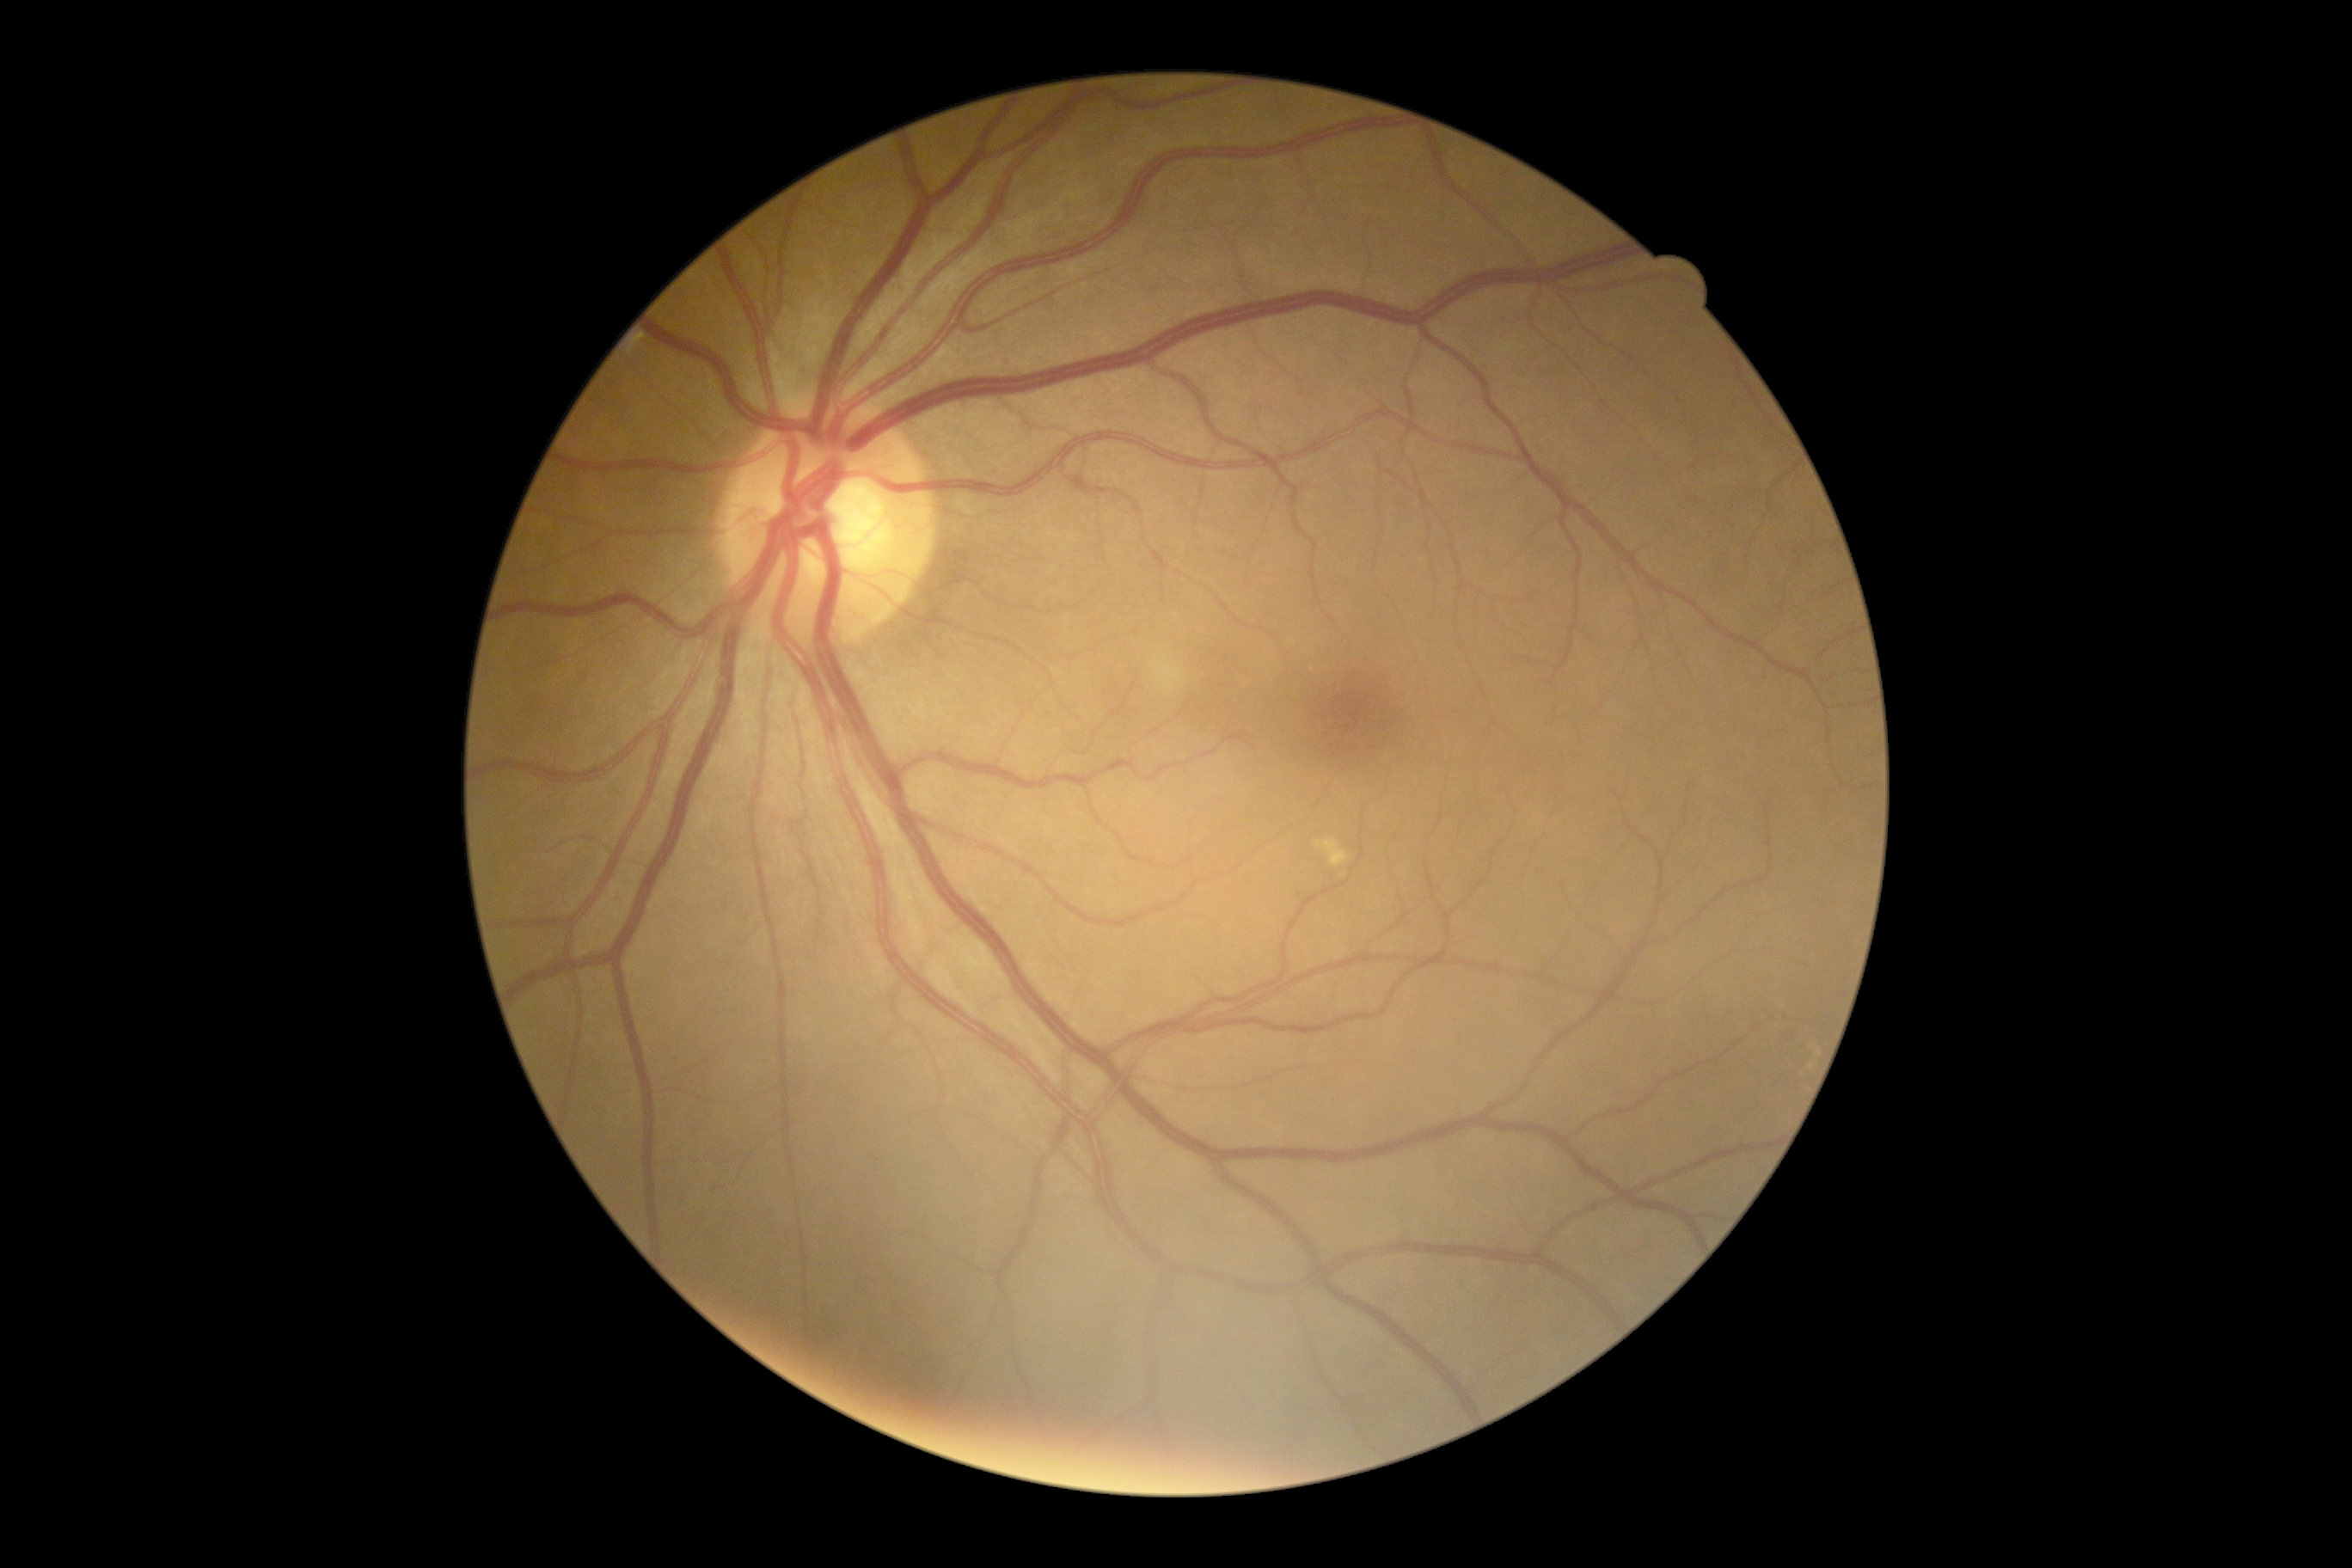

DR severity: no apparent diabetic retinopathy (grade 0).